Without pupil dilation, 848x848, 45° field of view, posterior pole color fundus photograph.
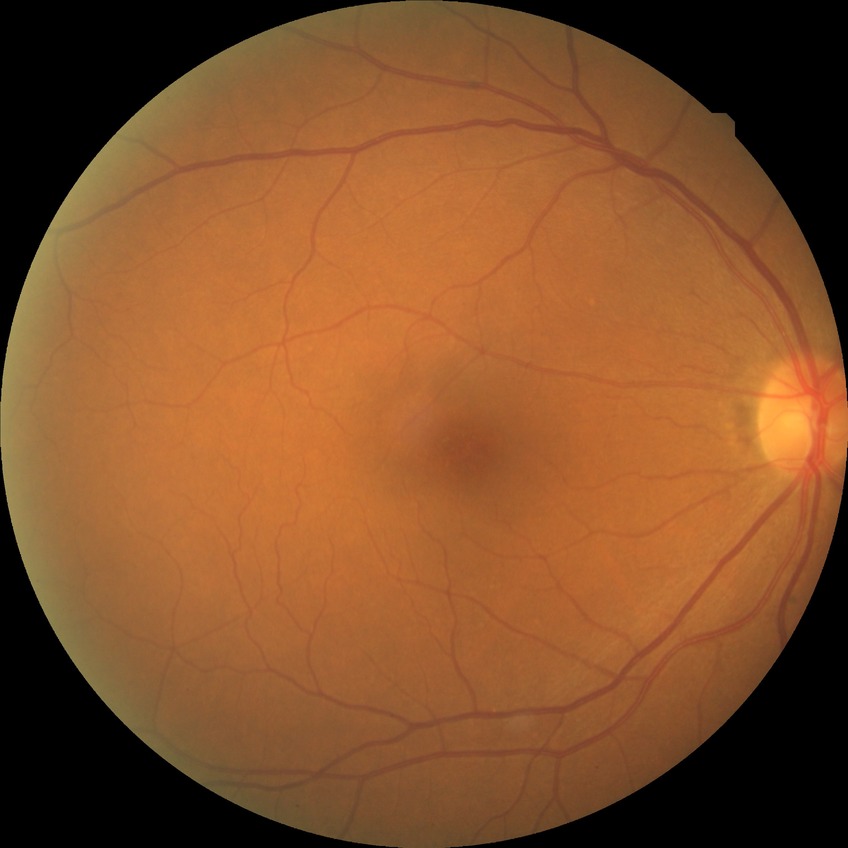 Diabetic retinopathy (DR): no diabetic retinopathy (NDR).